Mydriatic; optic disc-centered crop from a color fundus photograph — 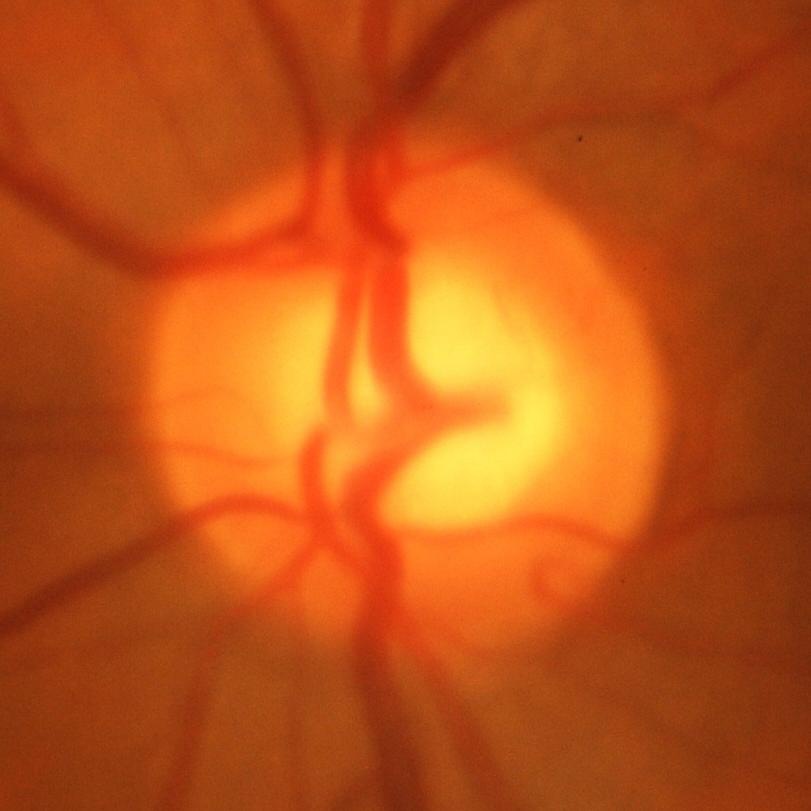
The image shows glaucomatous changes.